100° field of view (Phoenix ICON) · wide-field fundus image from infant ROP screening · 1240 x 1240 pixels
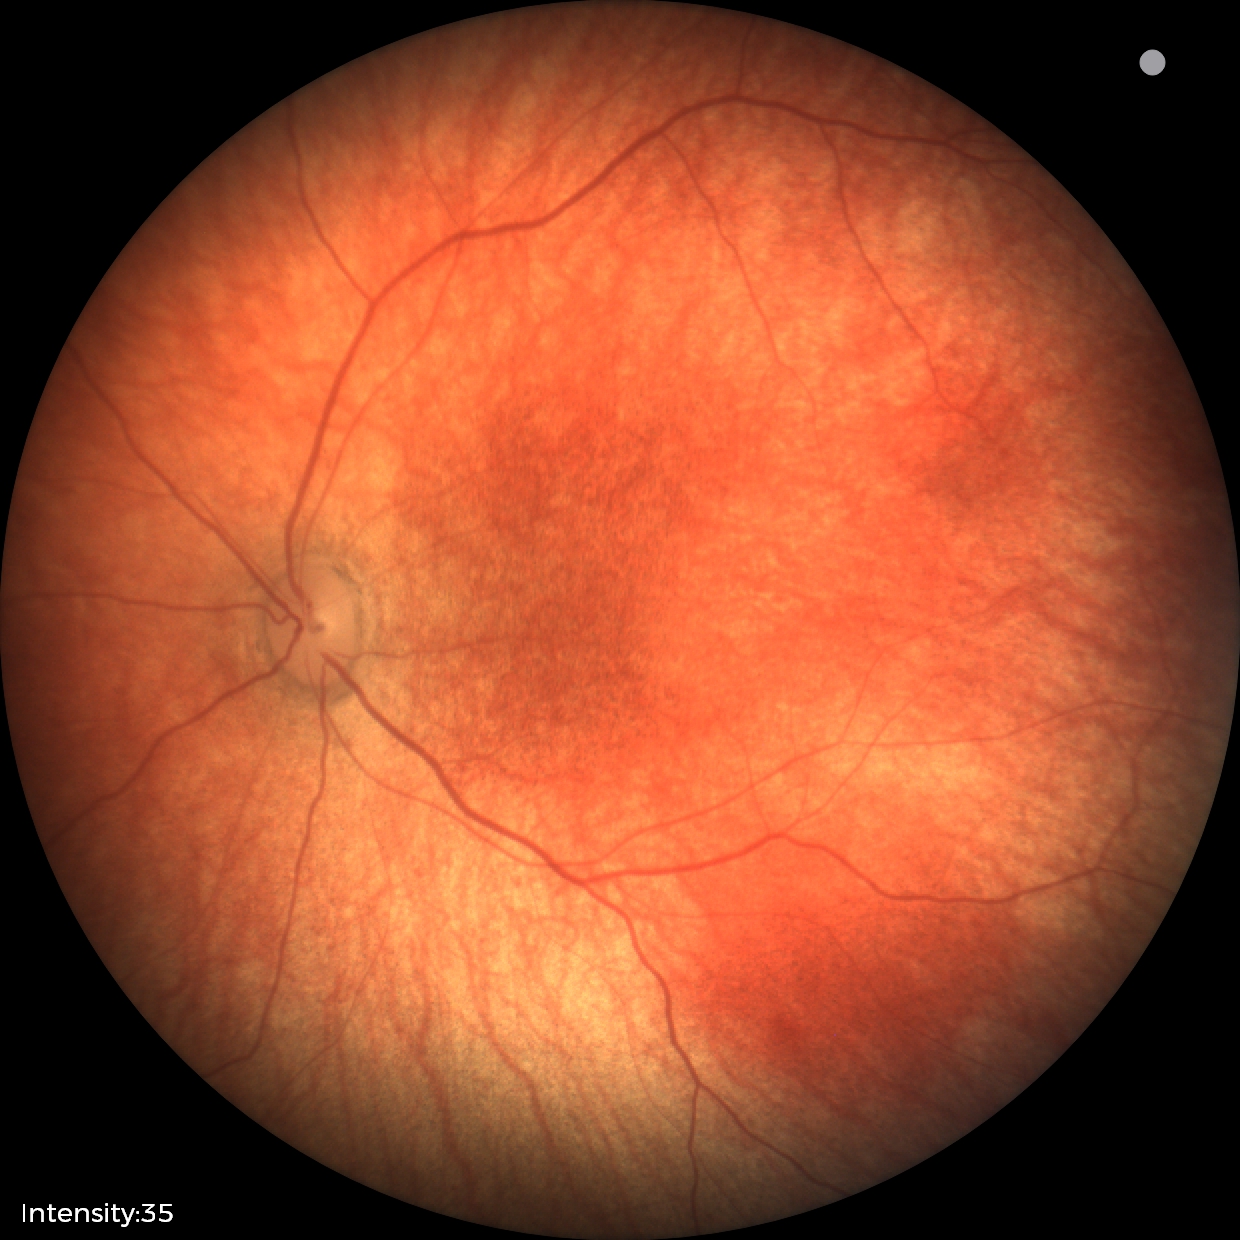

Normal screening examination.